Pediatric retinal photograph (wide-field):
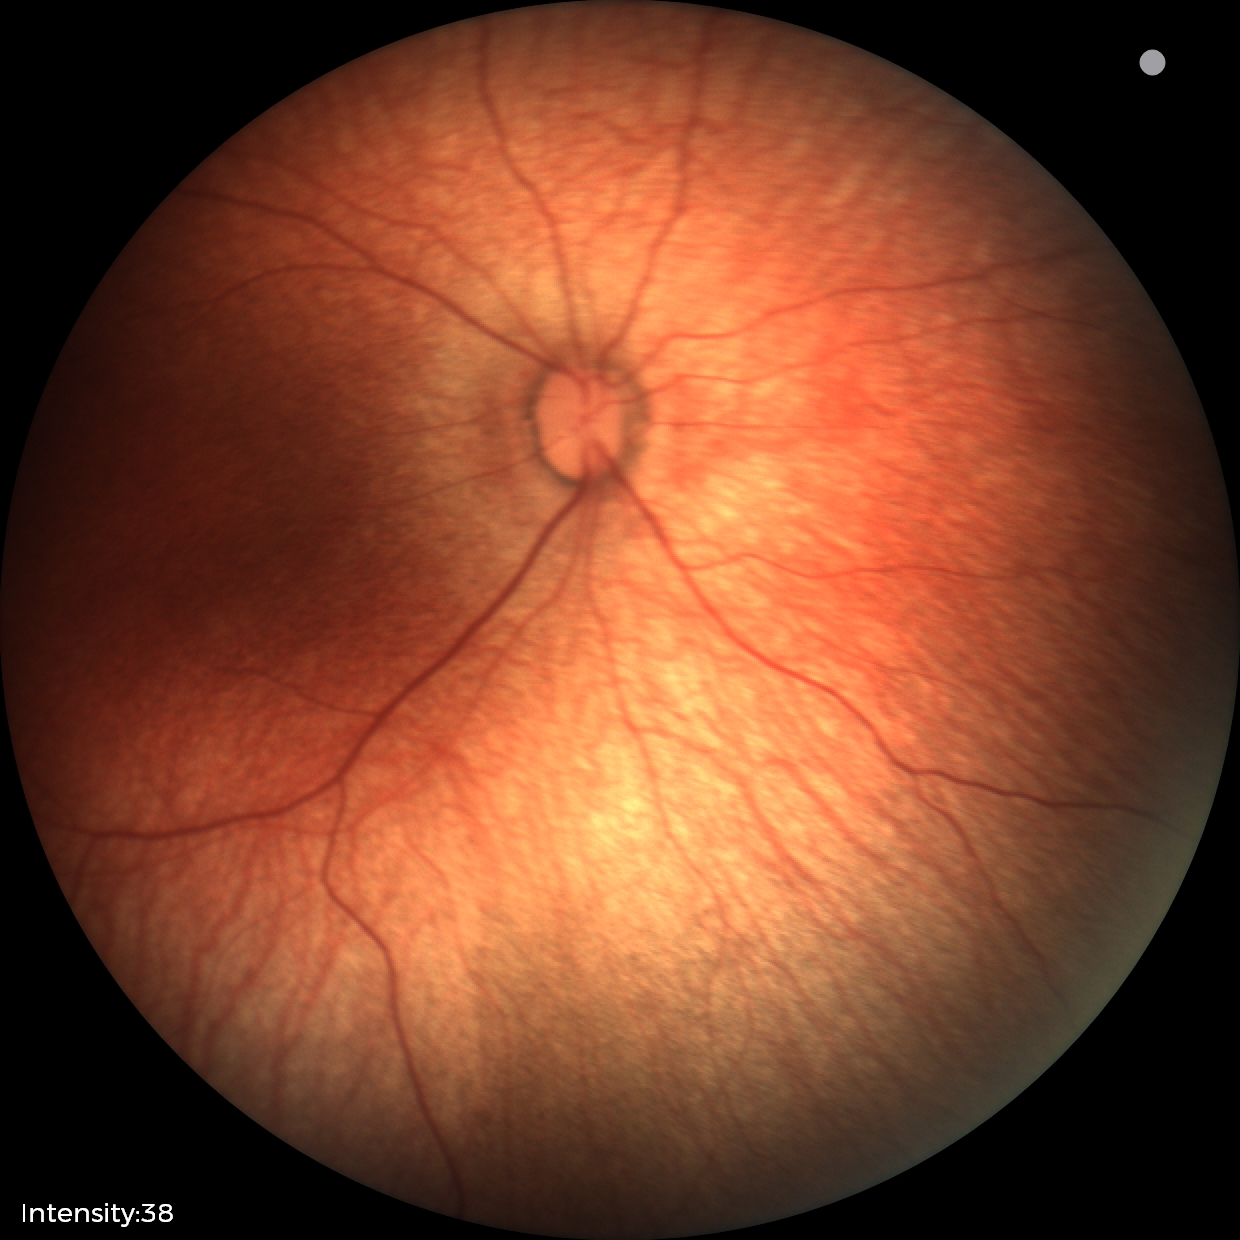
Screening: normal fundus examination.